Wide-field fundus photograph of an infant; 640 x 480 pixels; acquired on the Clarity RetCam 3: 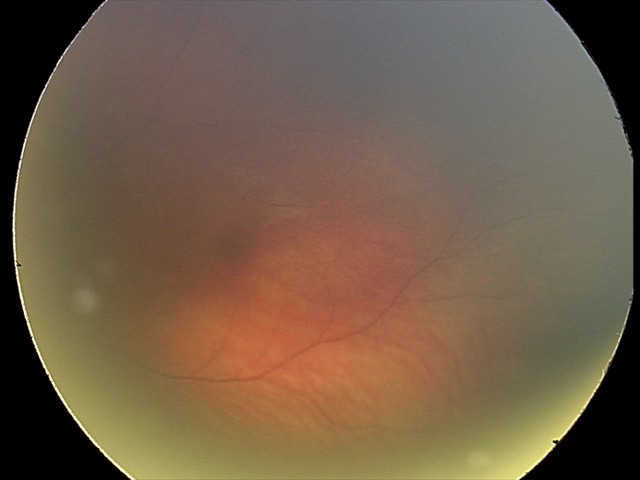
Q: What is the diagnosis from this examination?
A: retinal hemorrhages